2352x1568px. 45° FOV:
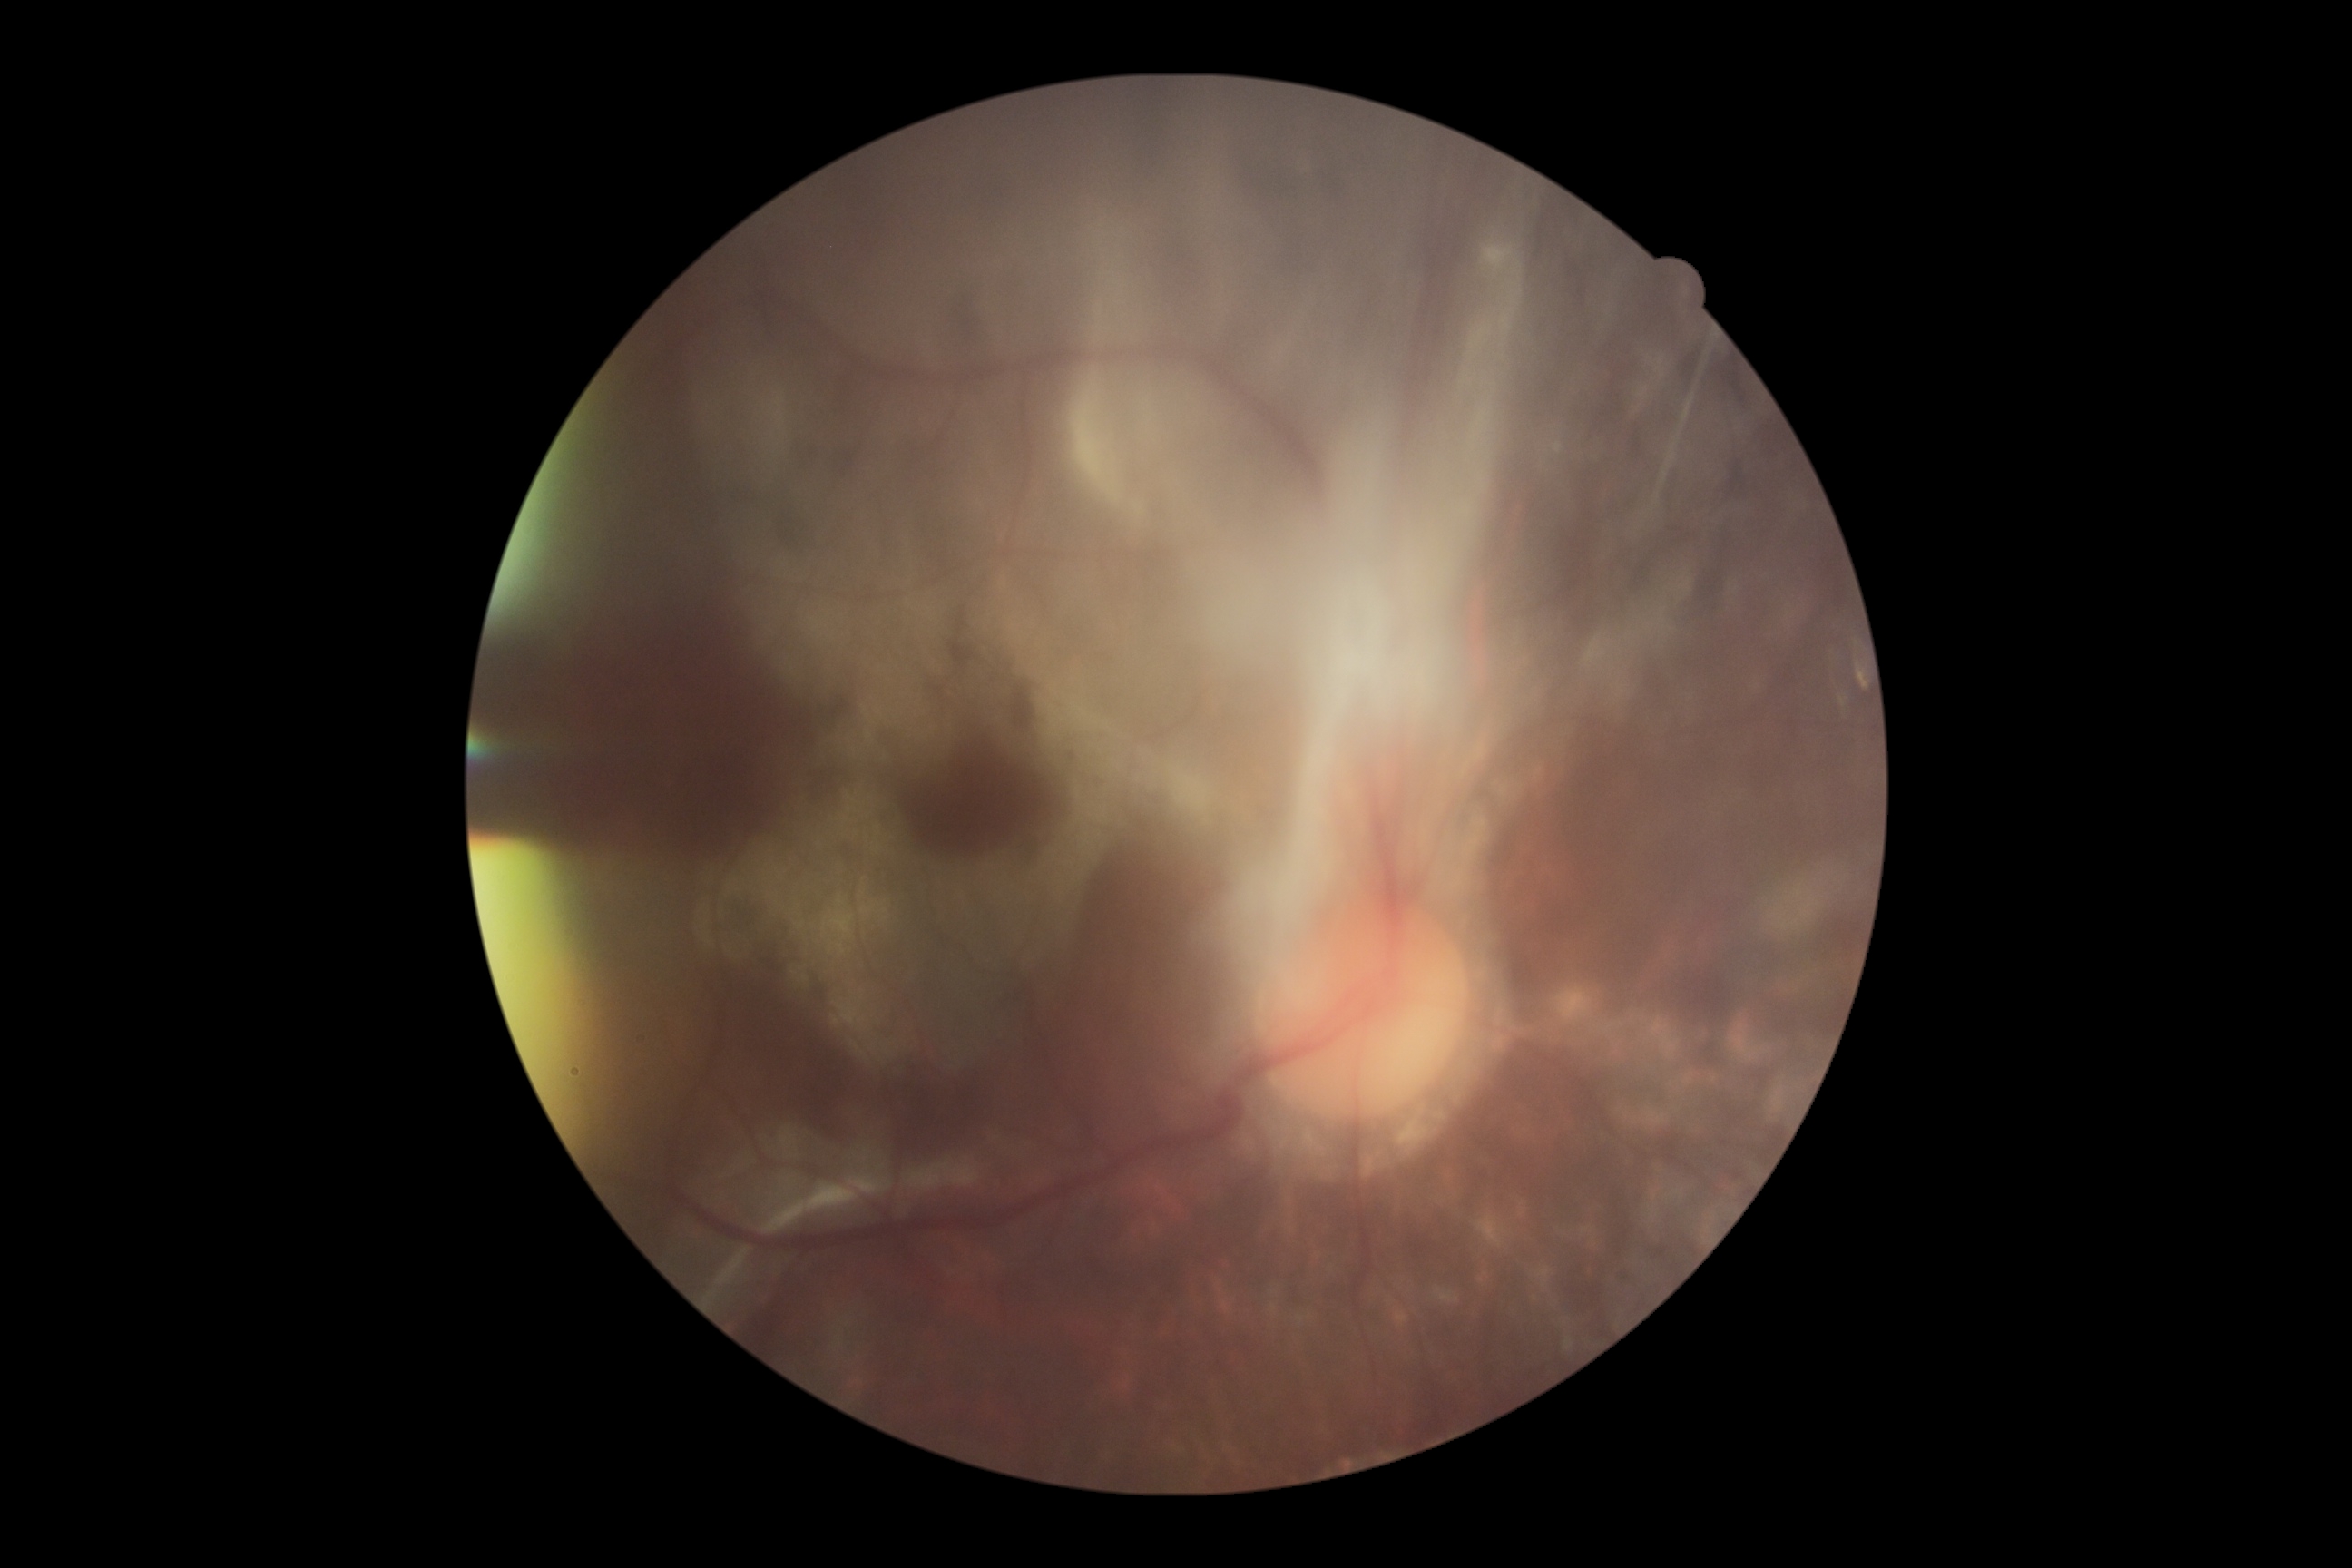   dr_grade: proliferative diabetic retinopathy (grade 4)